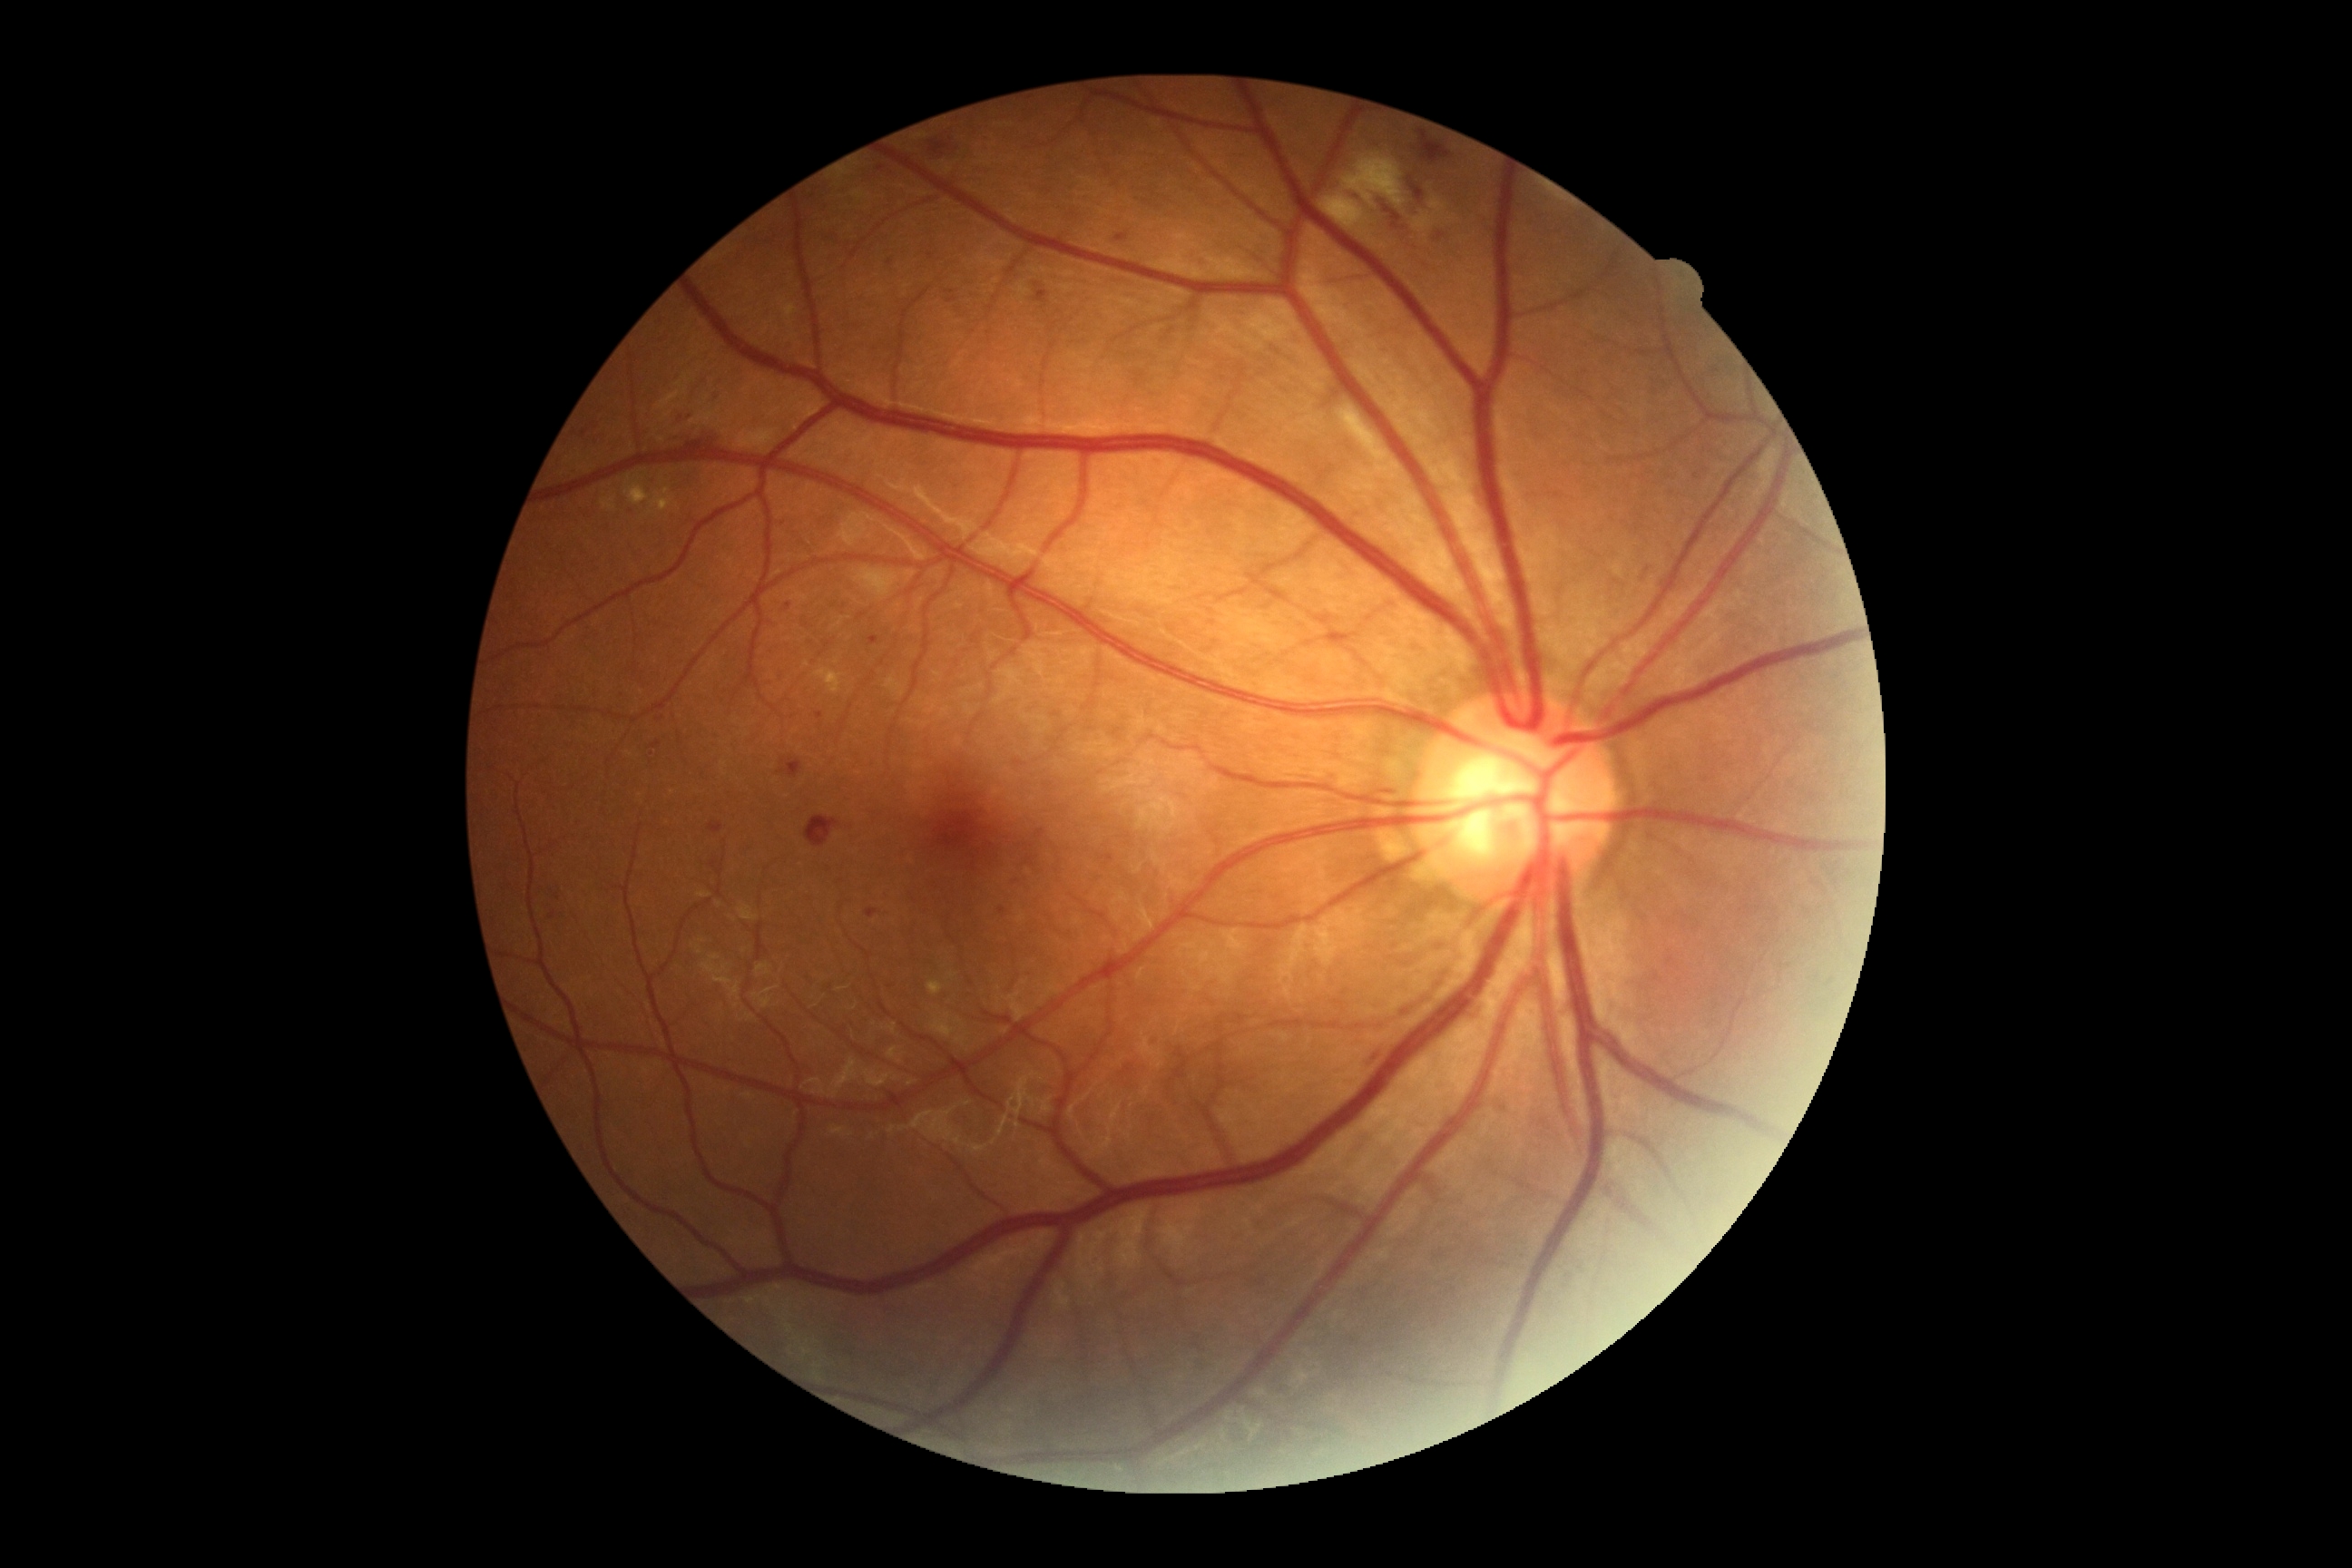
retinopathy: grade 2 (moderate NPDR).